45-degree field of view:
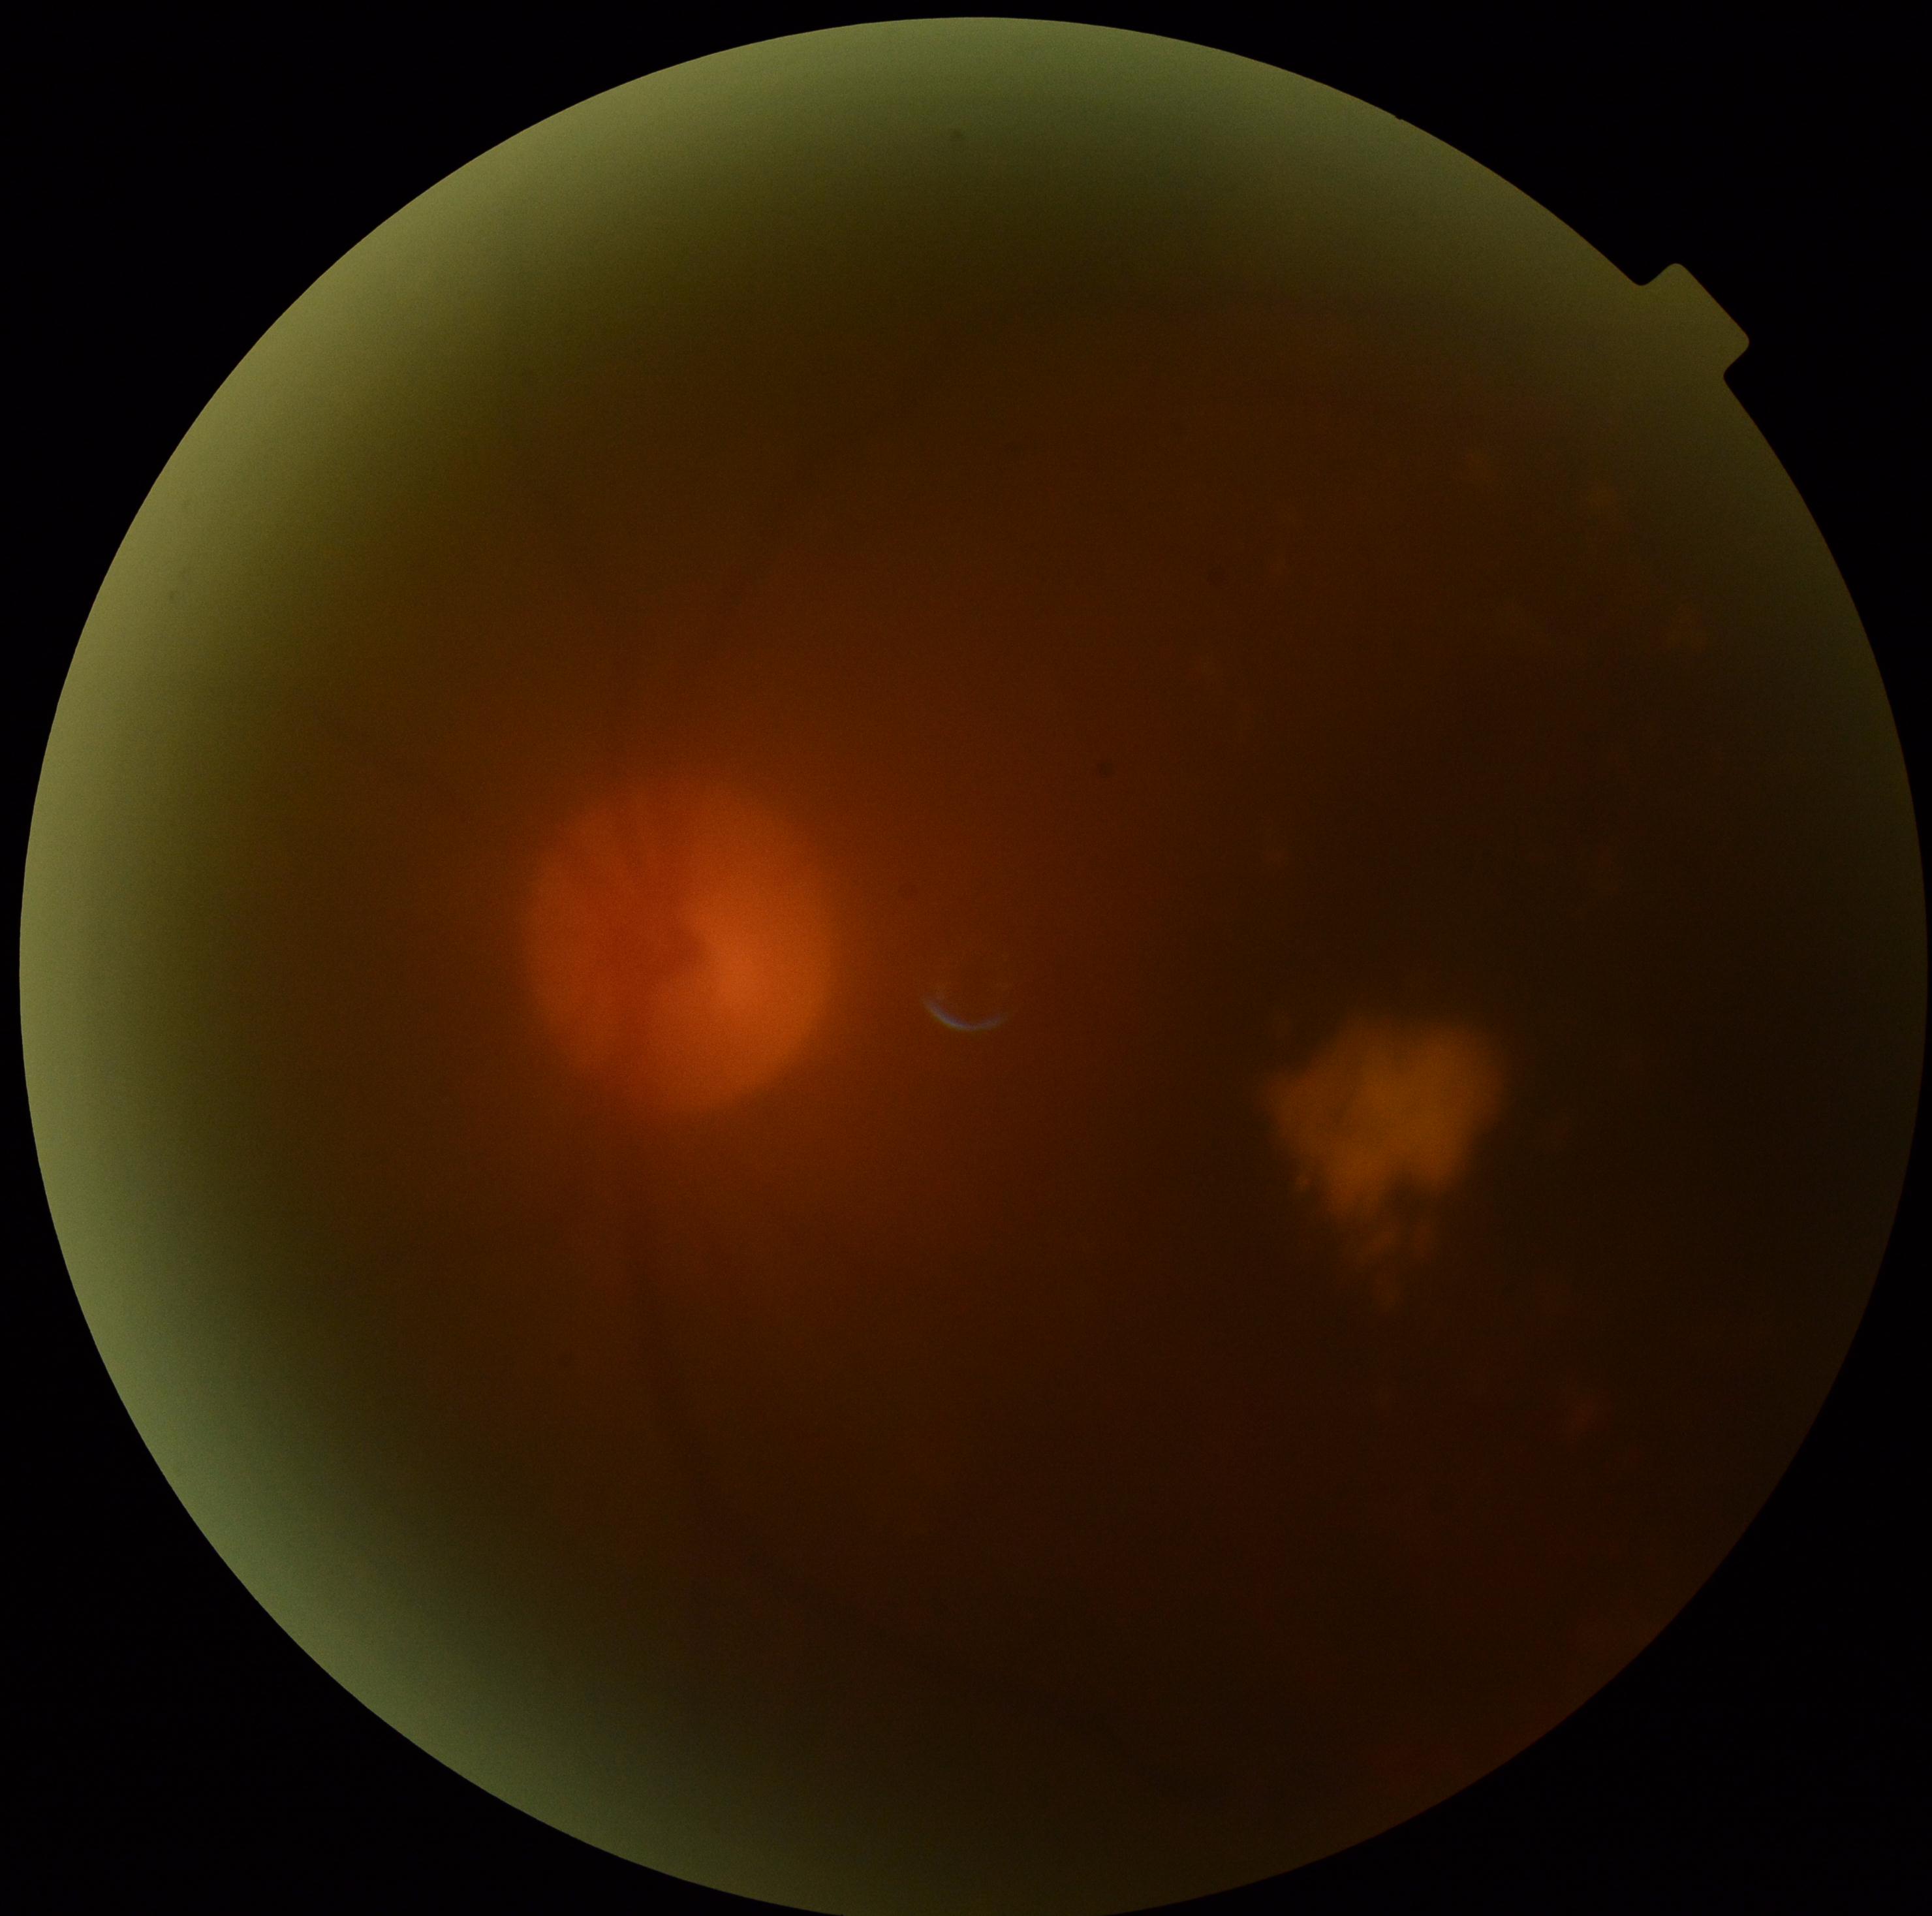 DR grade is moderate NPDR (2).